Wide-field fundus image from infant ROP screening. 640 by 480 pixels: 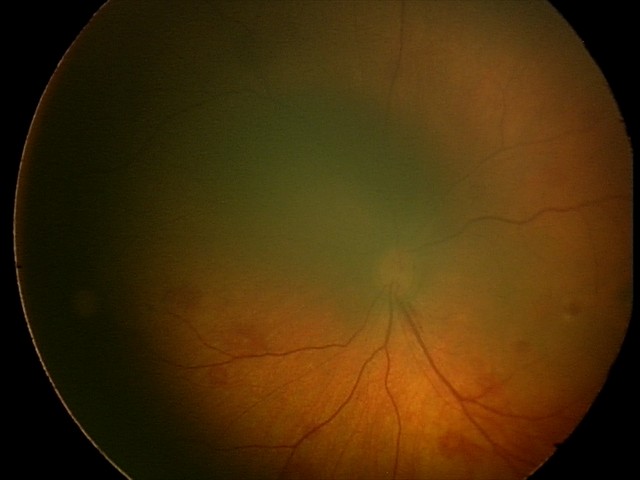
Screening series with retinal hemorrhages.